Image size 1240x1240. Phoenix ICON wide-field infant fundus image. 100° field of view (Phoenix ICON):
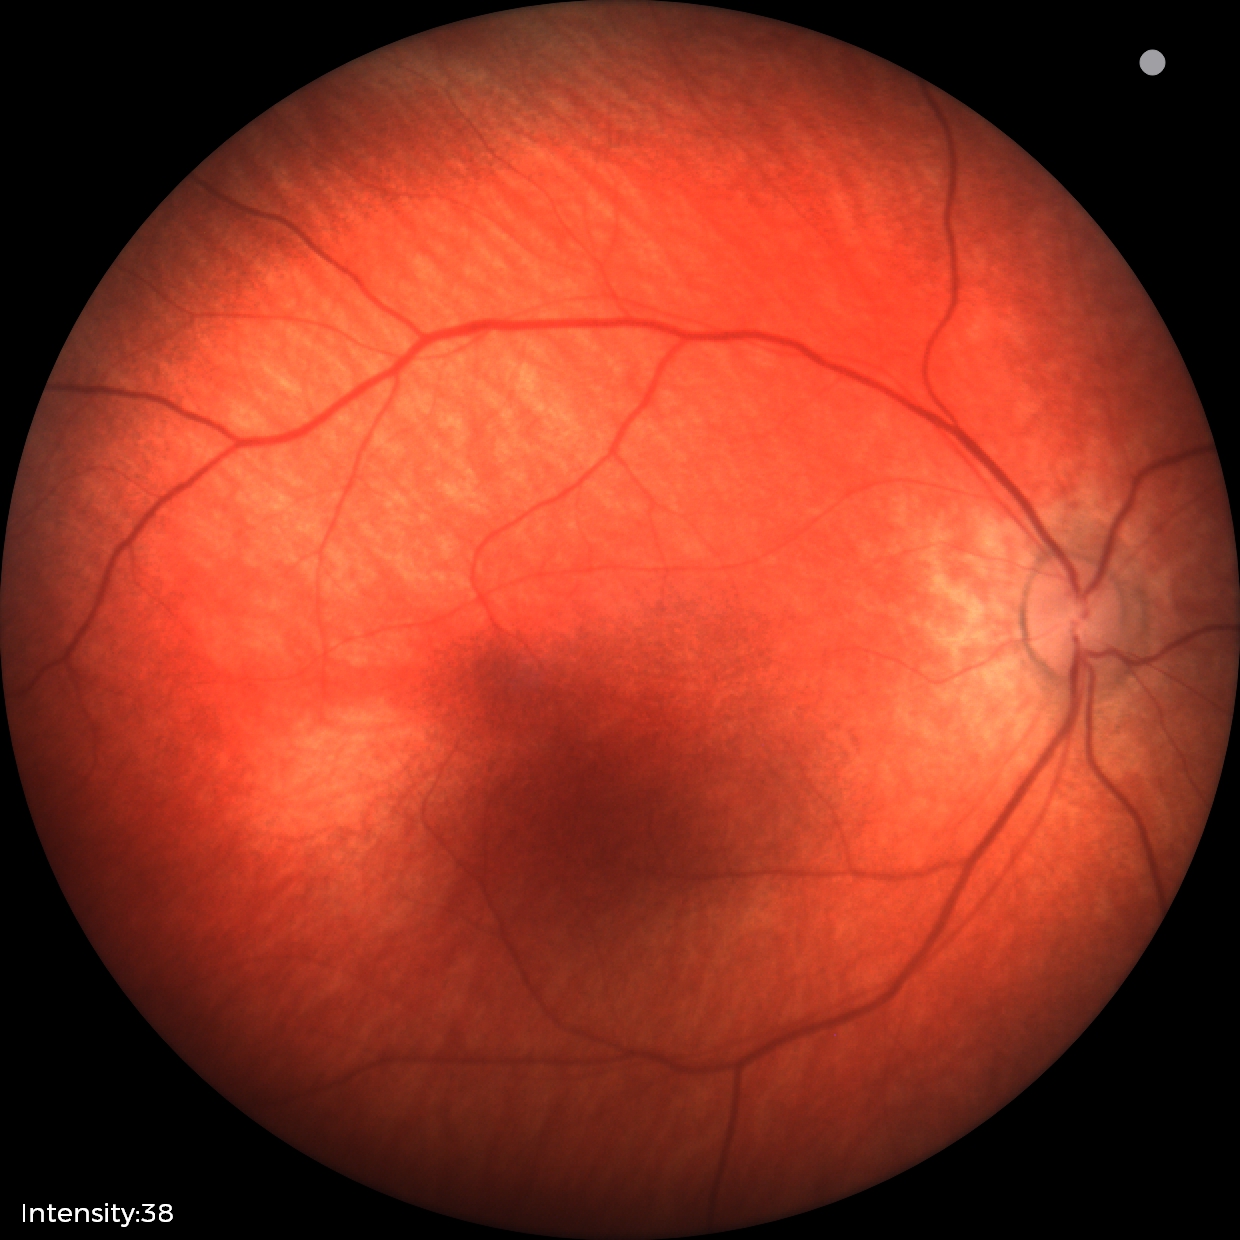 Impression: physiological appearance with no retinal pathology.